45° field of view. CFP. Image size 1932x1916:
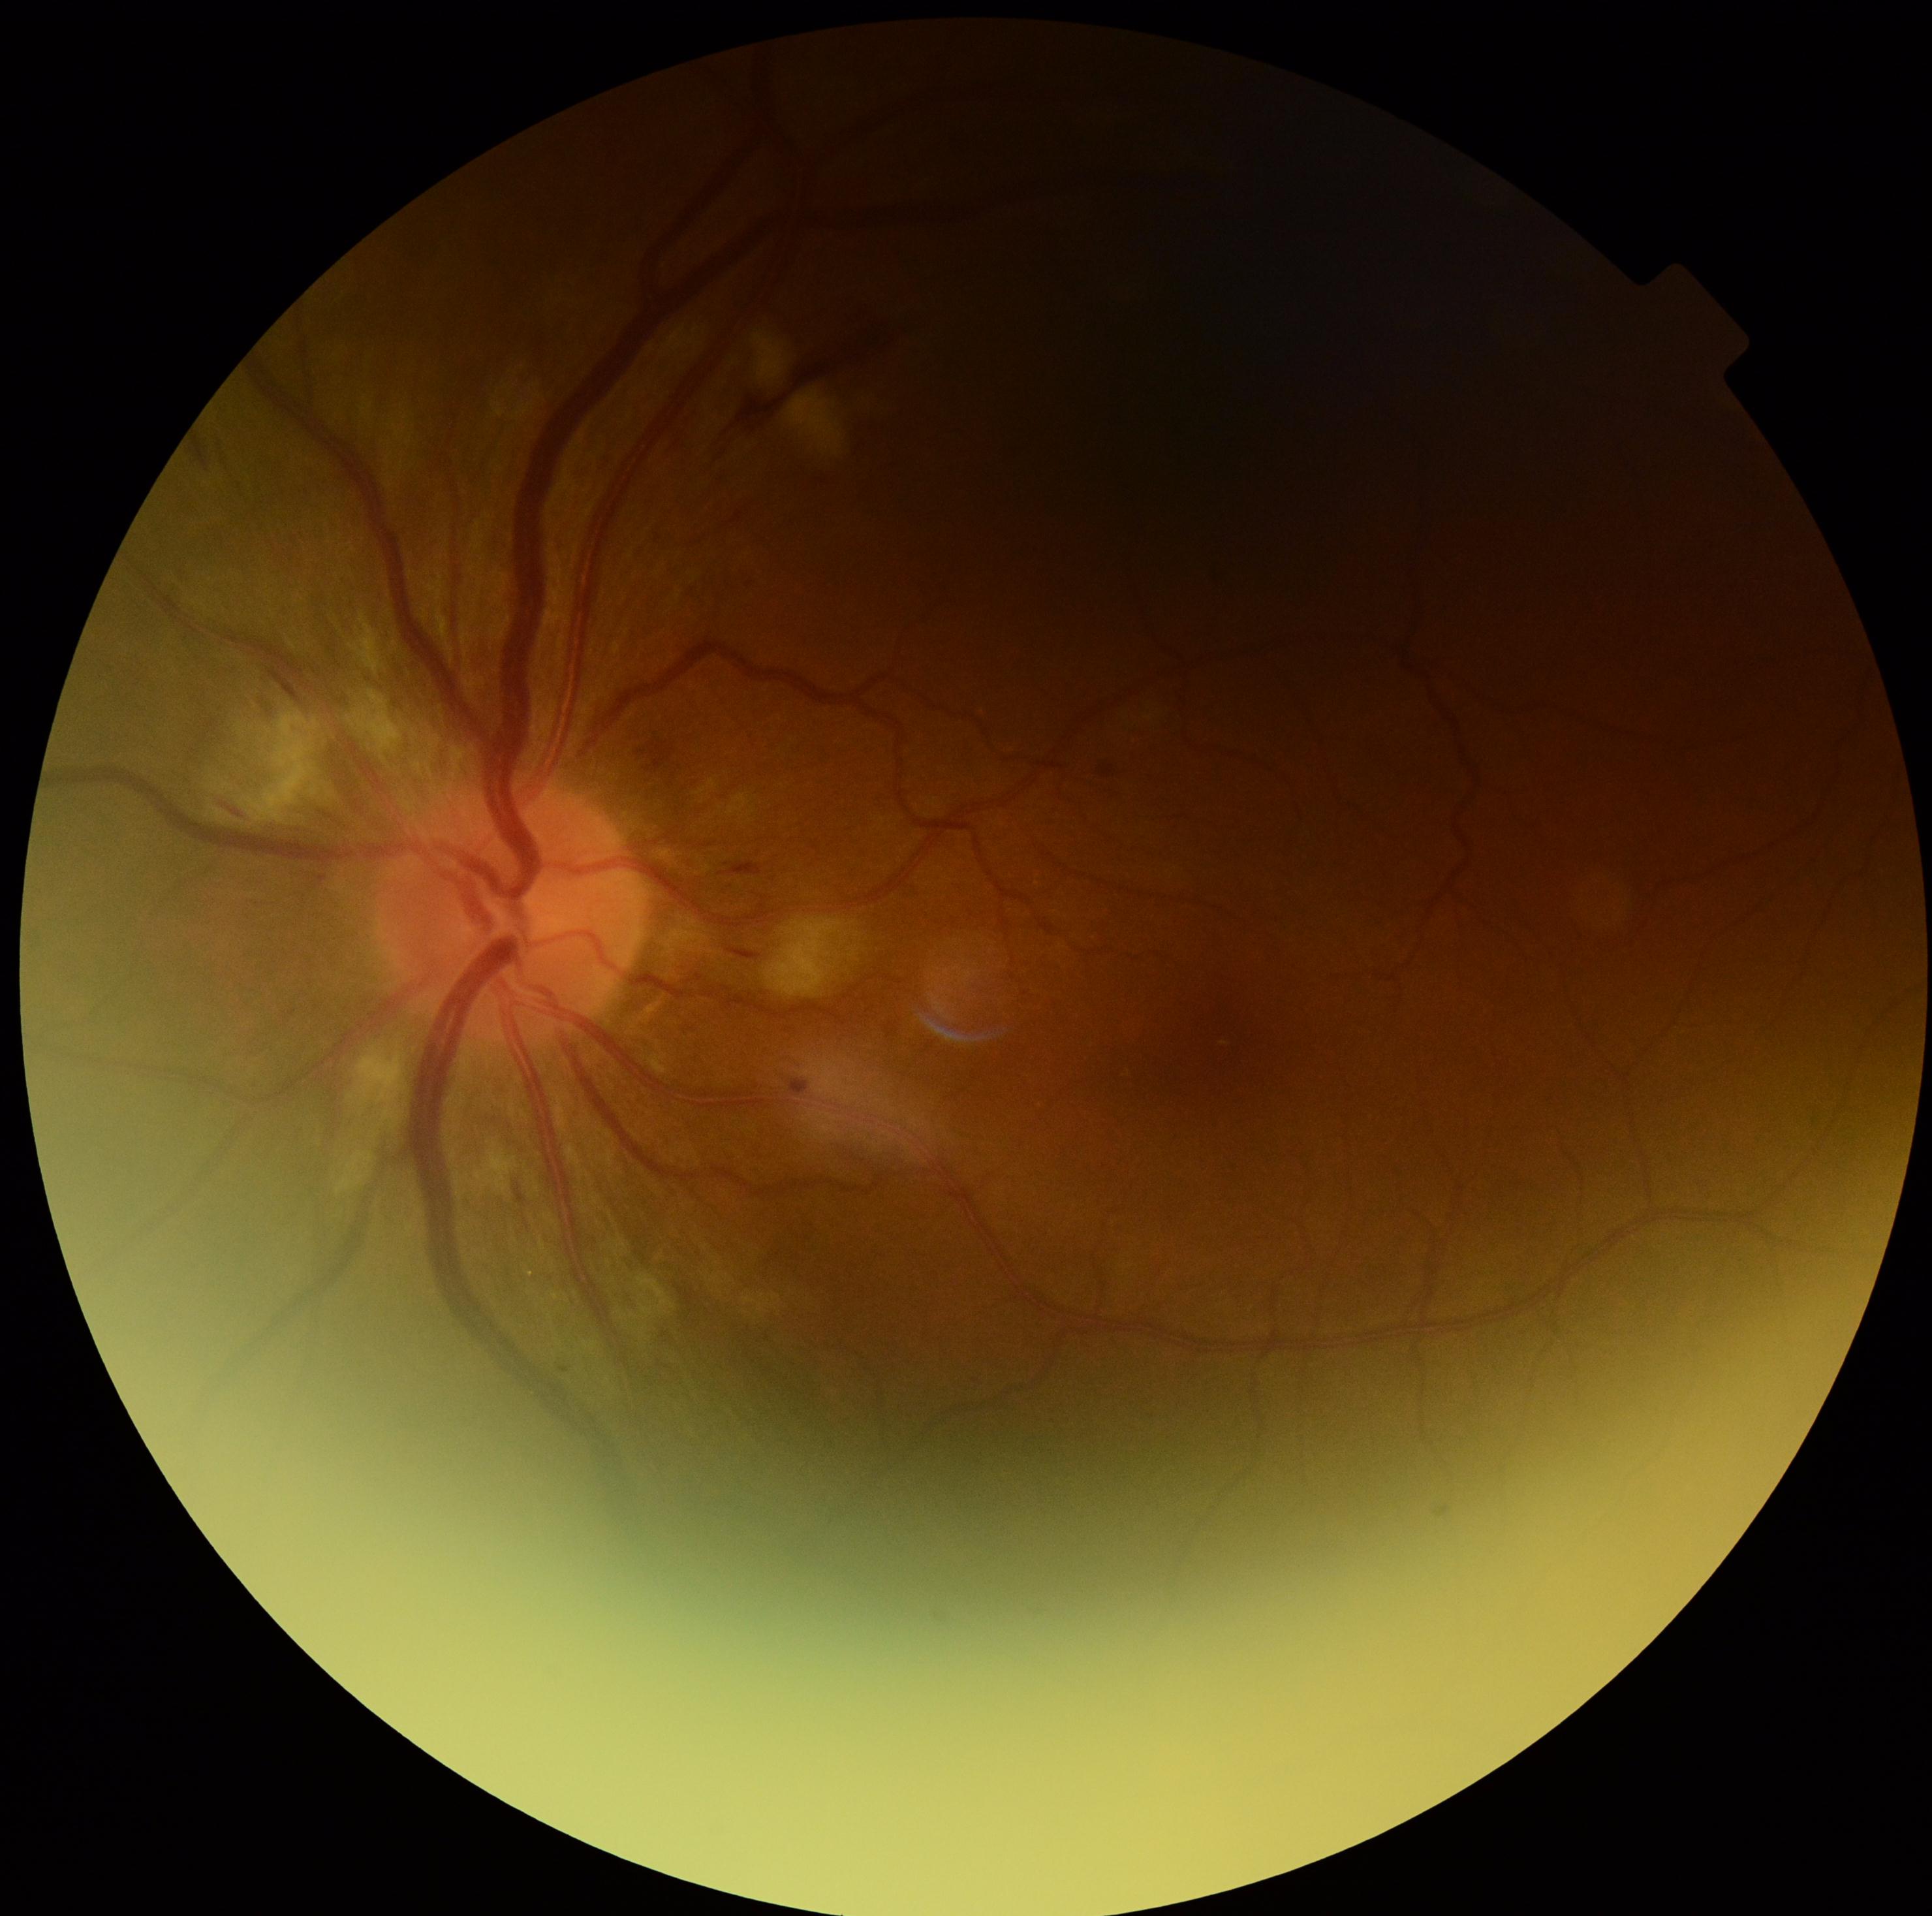 {
  "dr_grade": "grade 2 (moderate NPDR) — more than just microaneurysms but less than severe NPDR"
}